1659x2212px
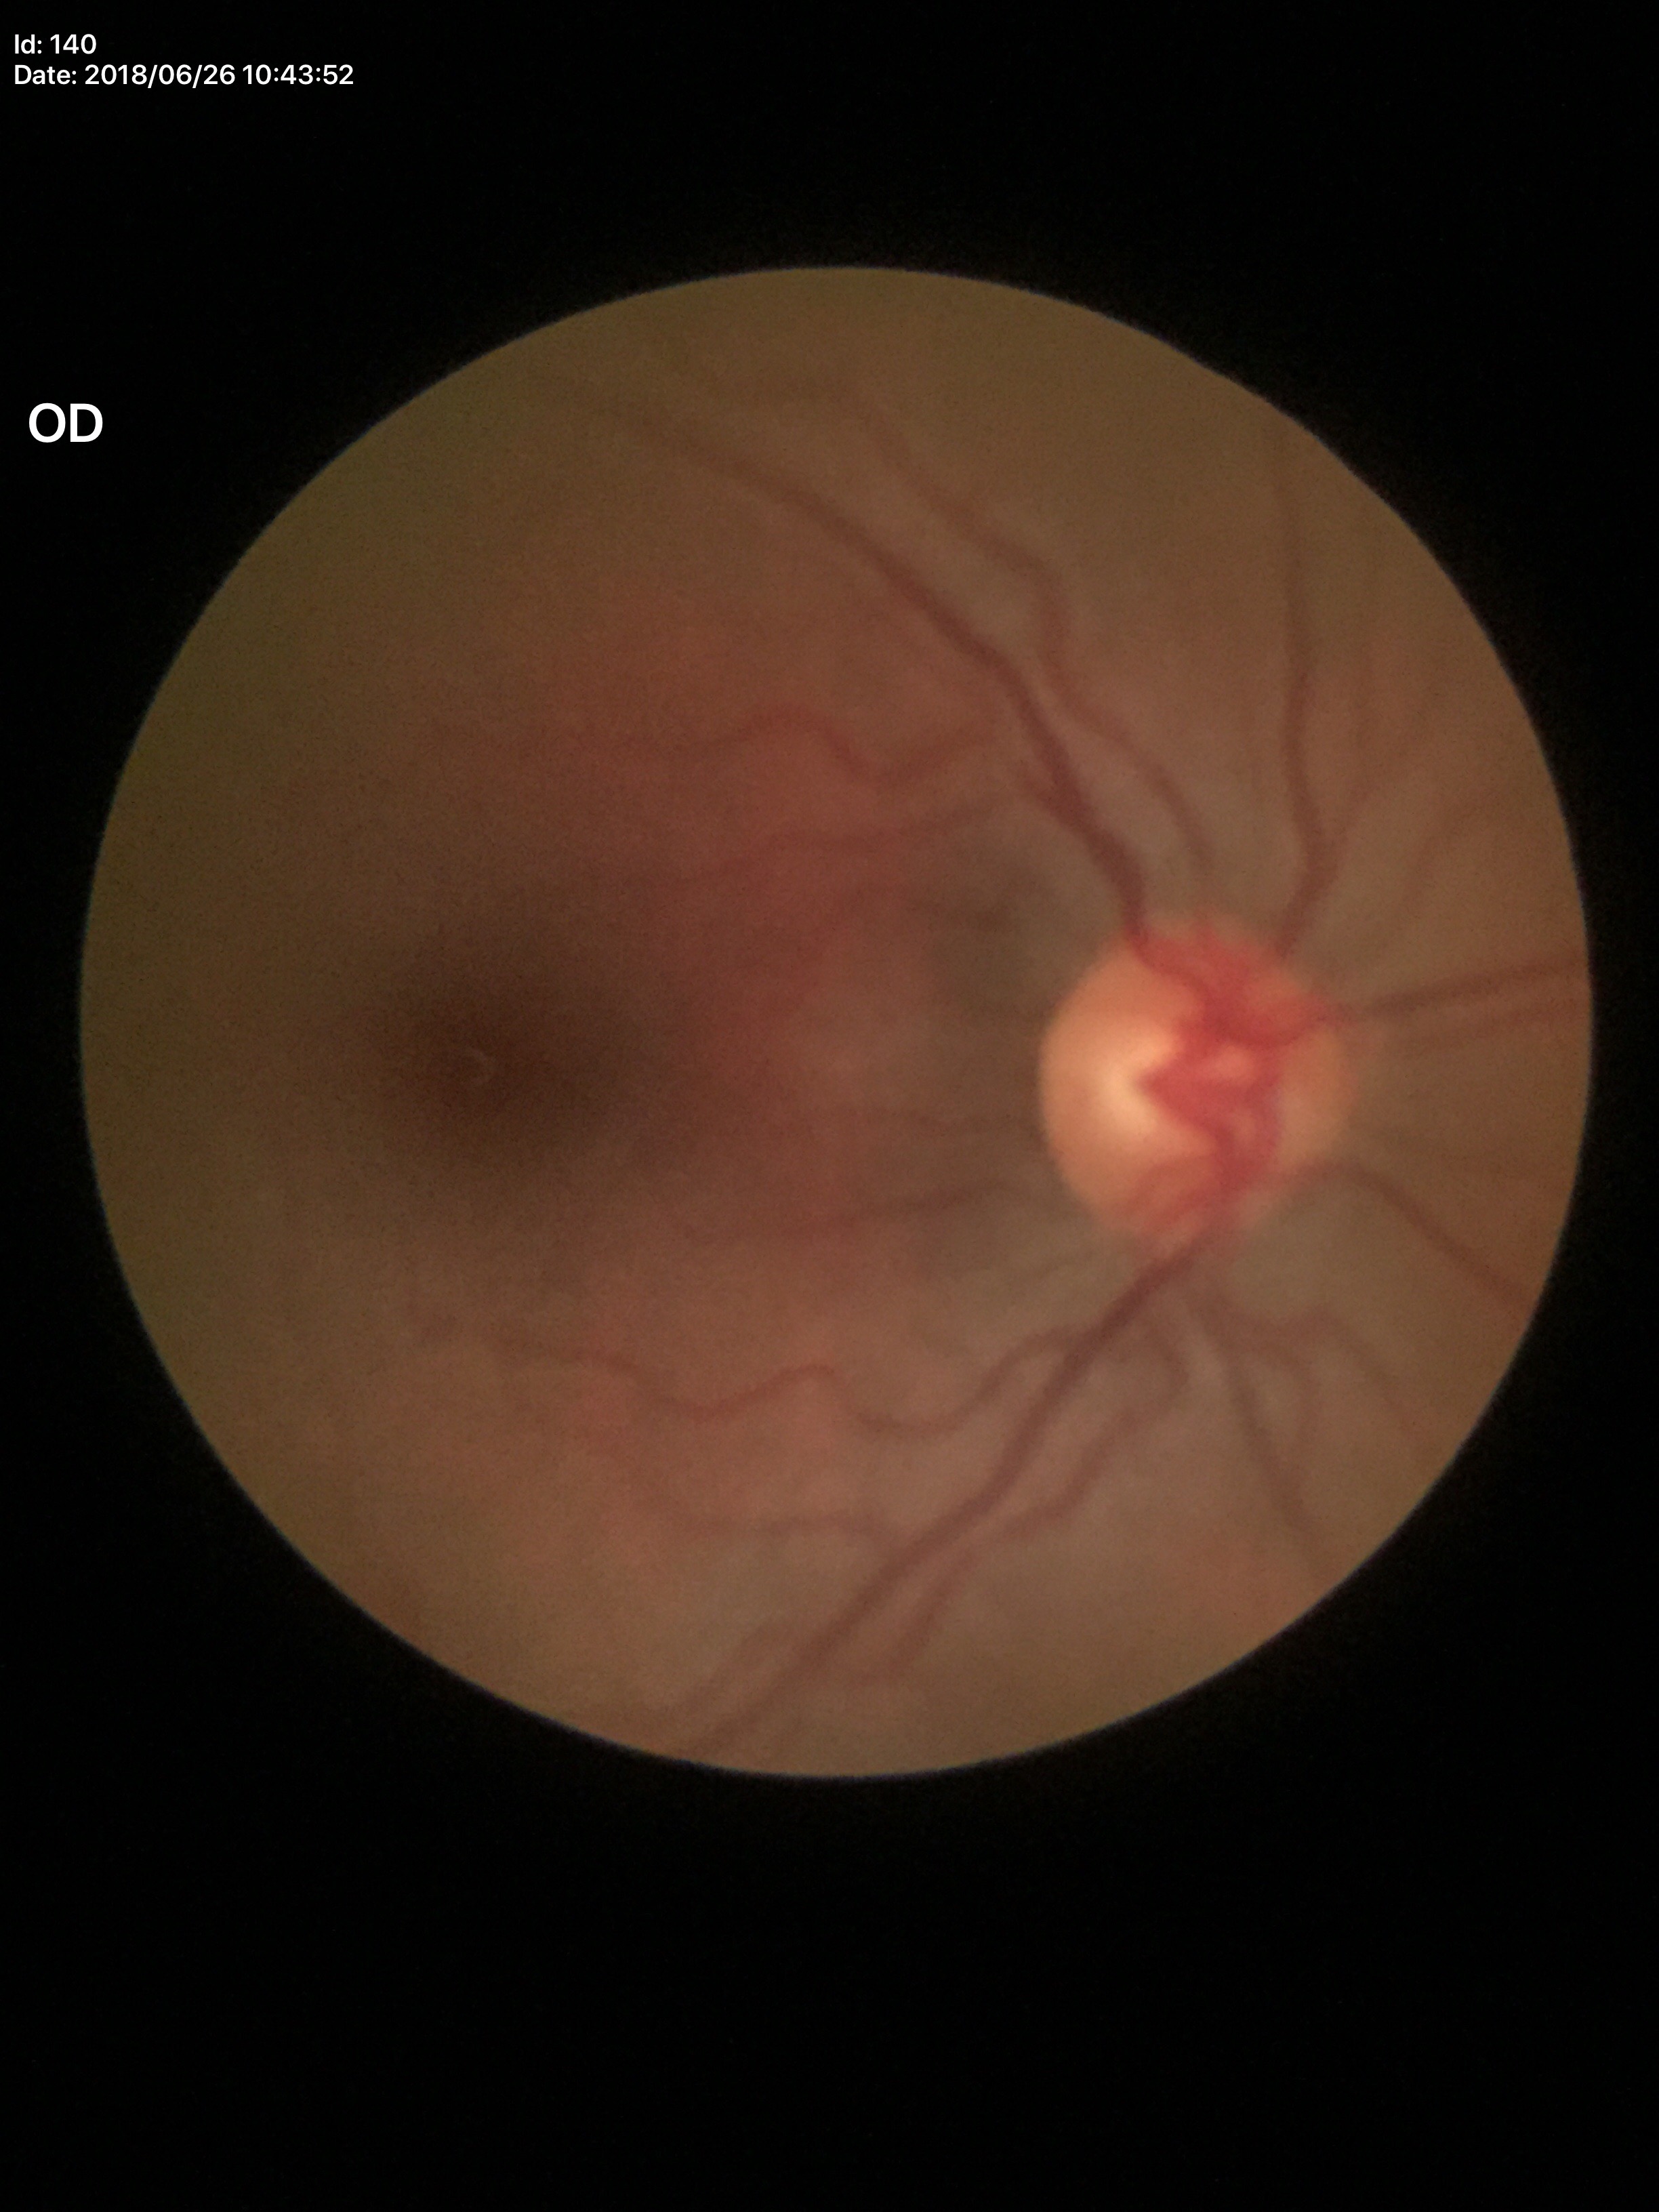
Negative for glaucoma suspicion (all 5 graders called normal). Area cup-to-disc ratio (ACDR): 0.27. Vertical cup-disc ratio (VCDR) of 0.48.